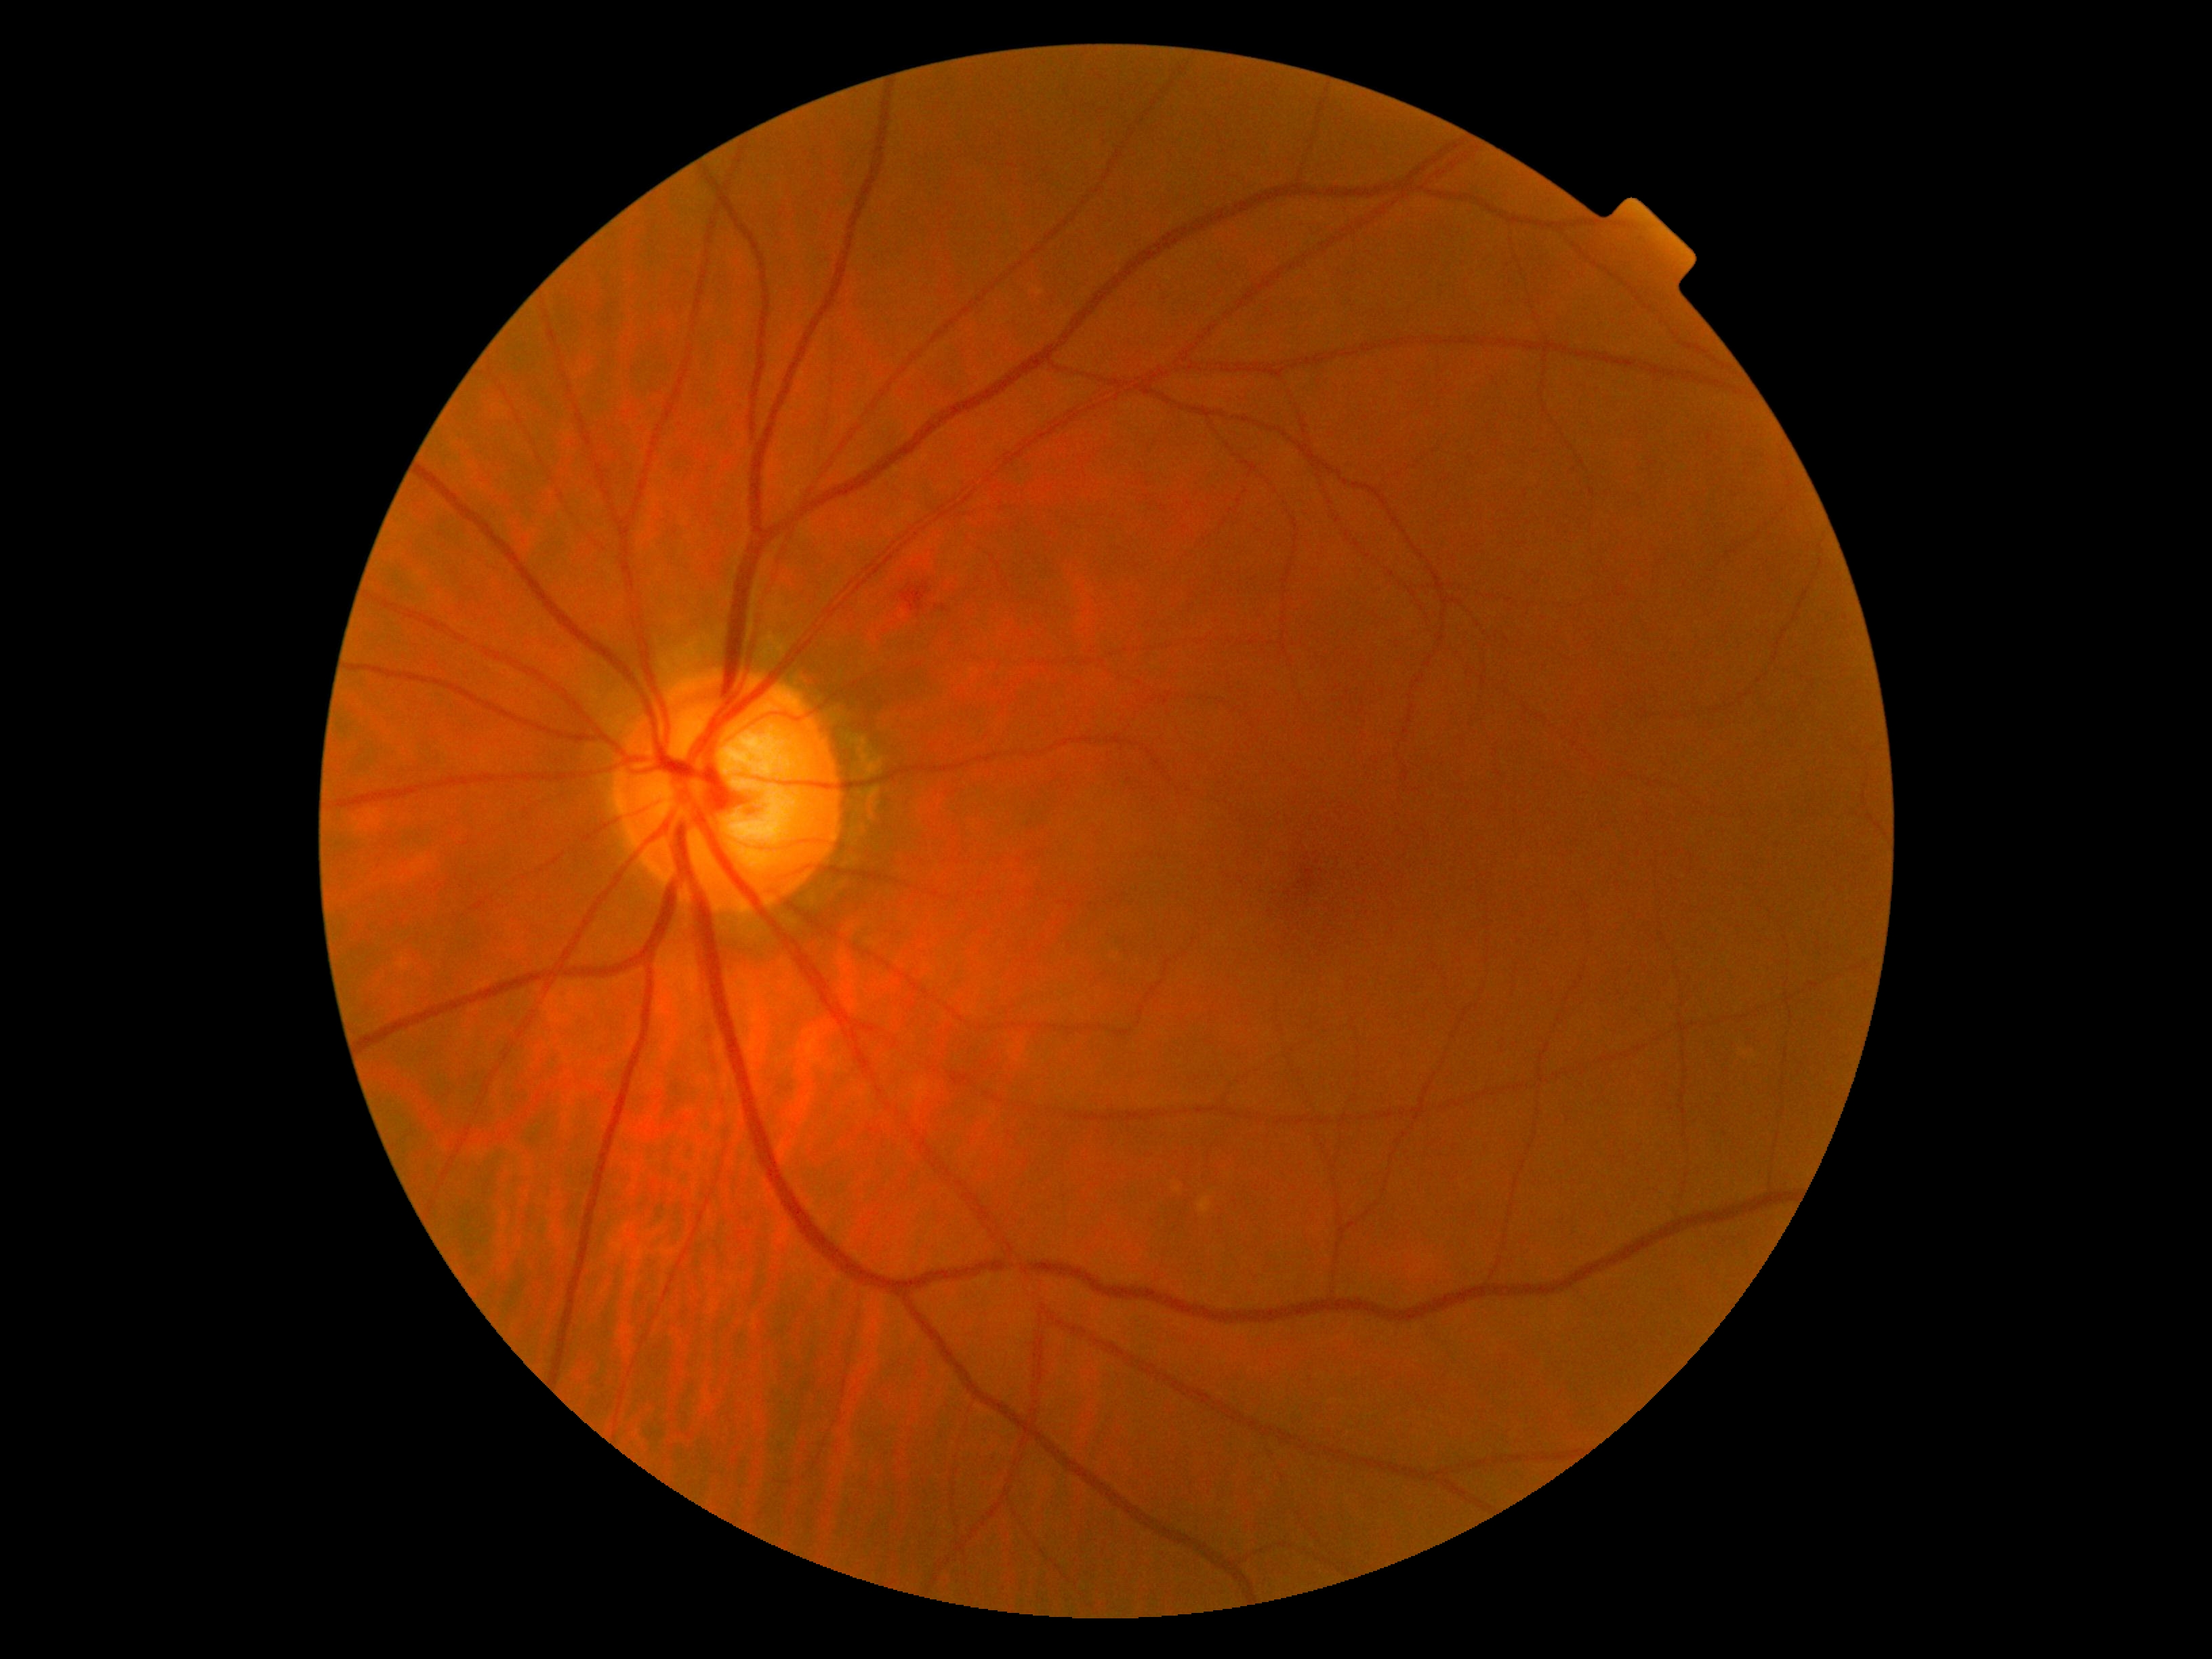

Findings:
• diabetic retinopathy grade — 2